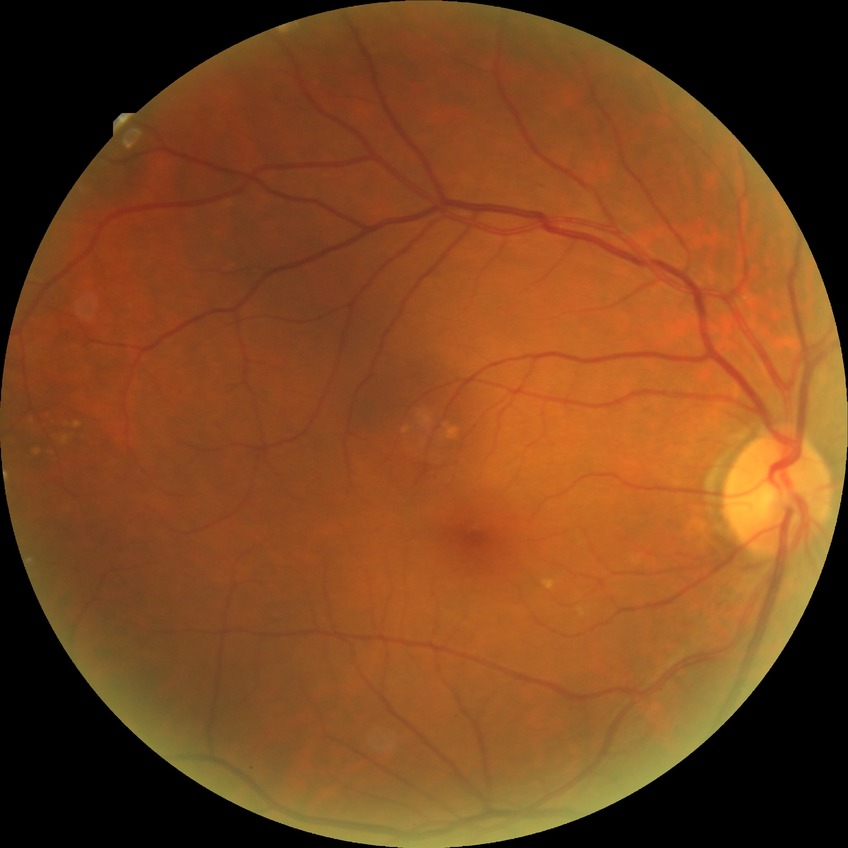 Davis DR grade is NDR. No diabetic retinal disease findings.